CFP — 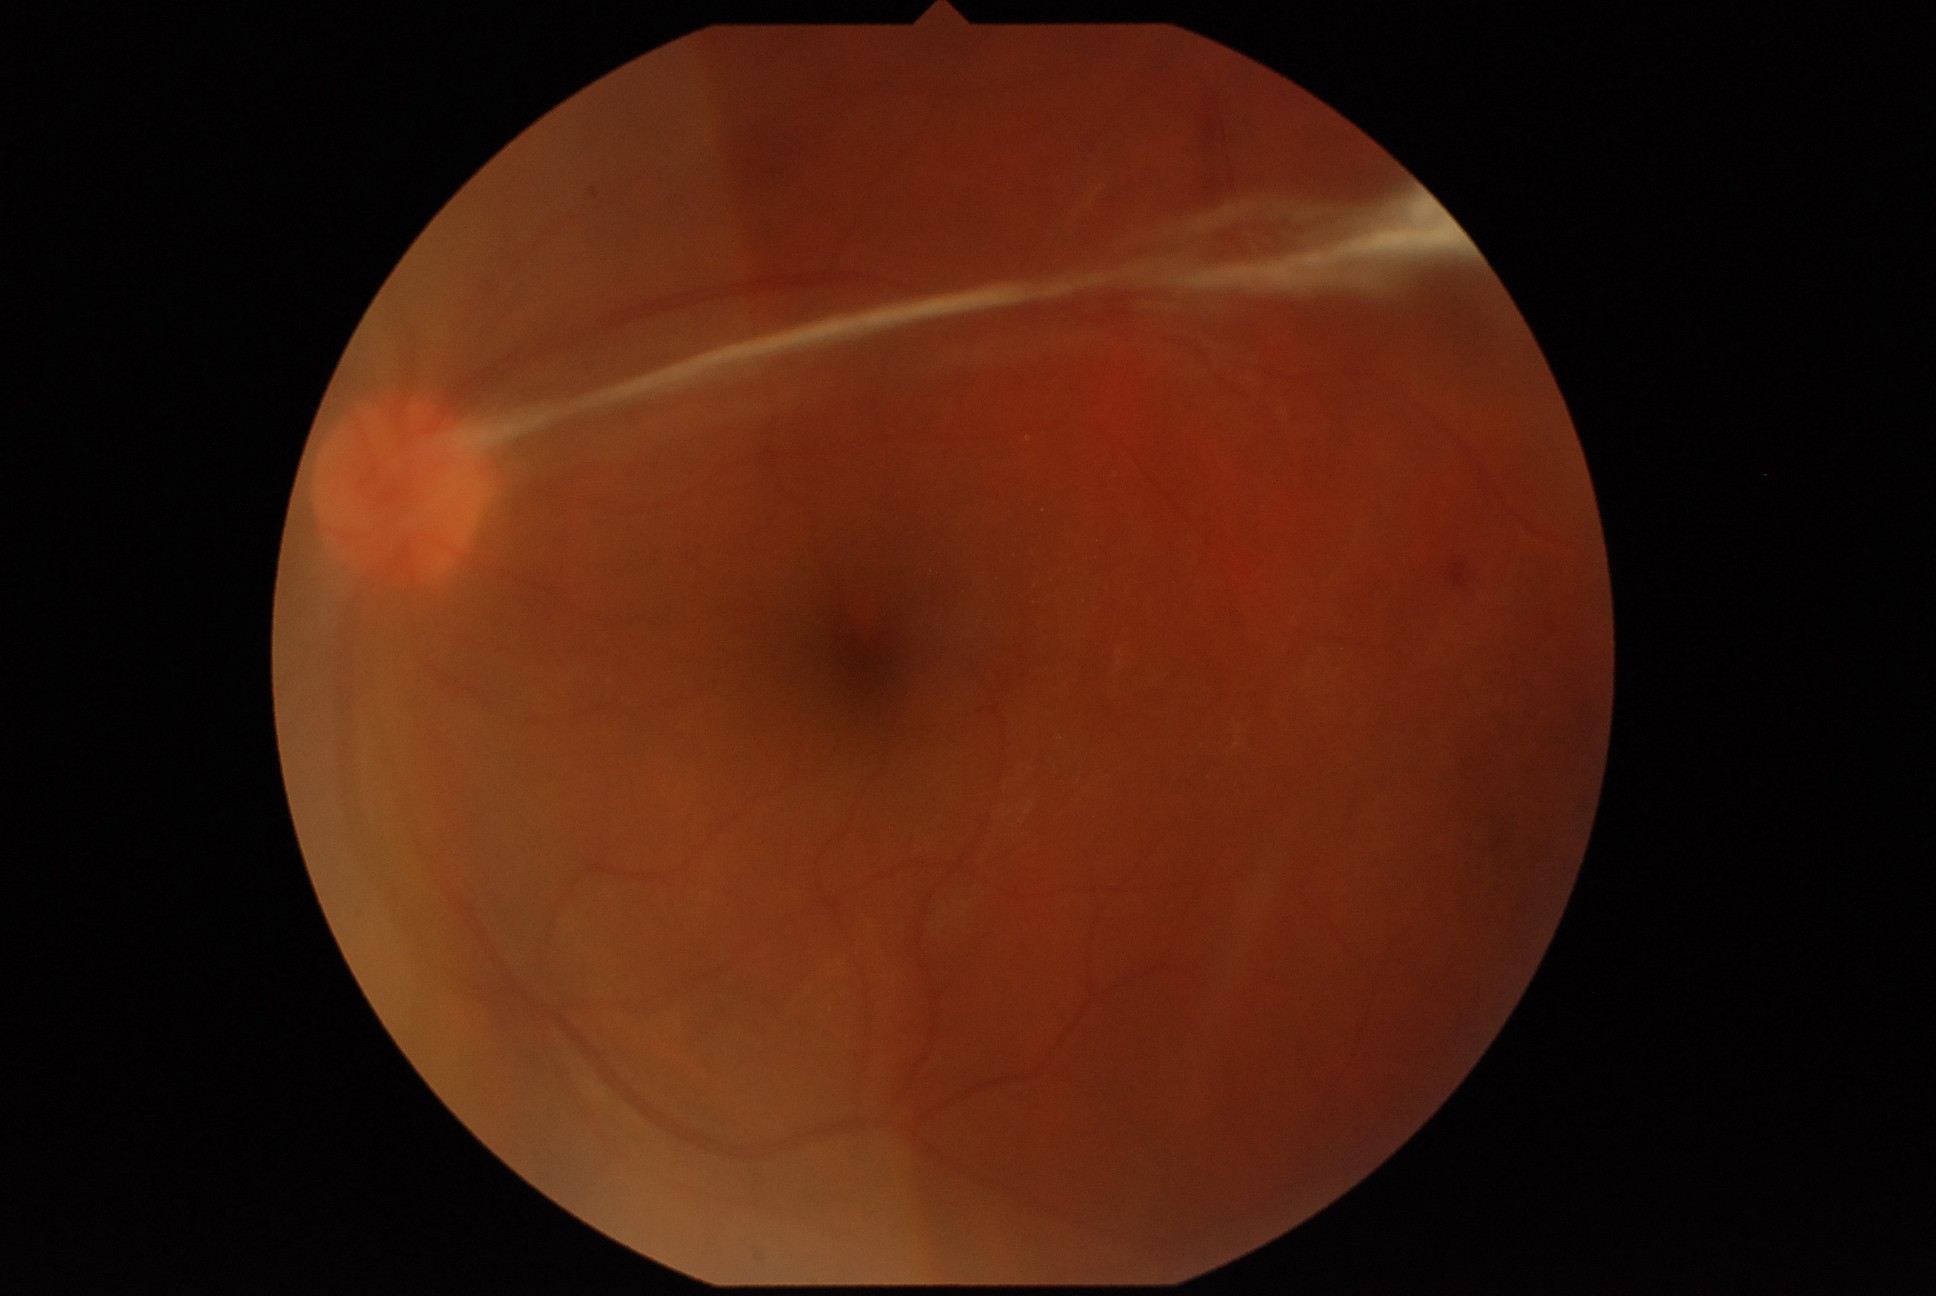
DR is grade 4.